Wide-field fundus photograph of an infant — 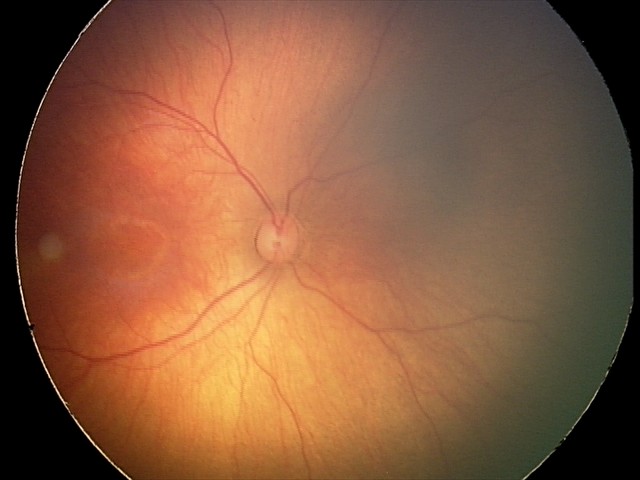
Physiological retinal appearance for postconceptual age.